FOV: 45 degrees.
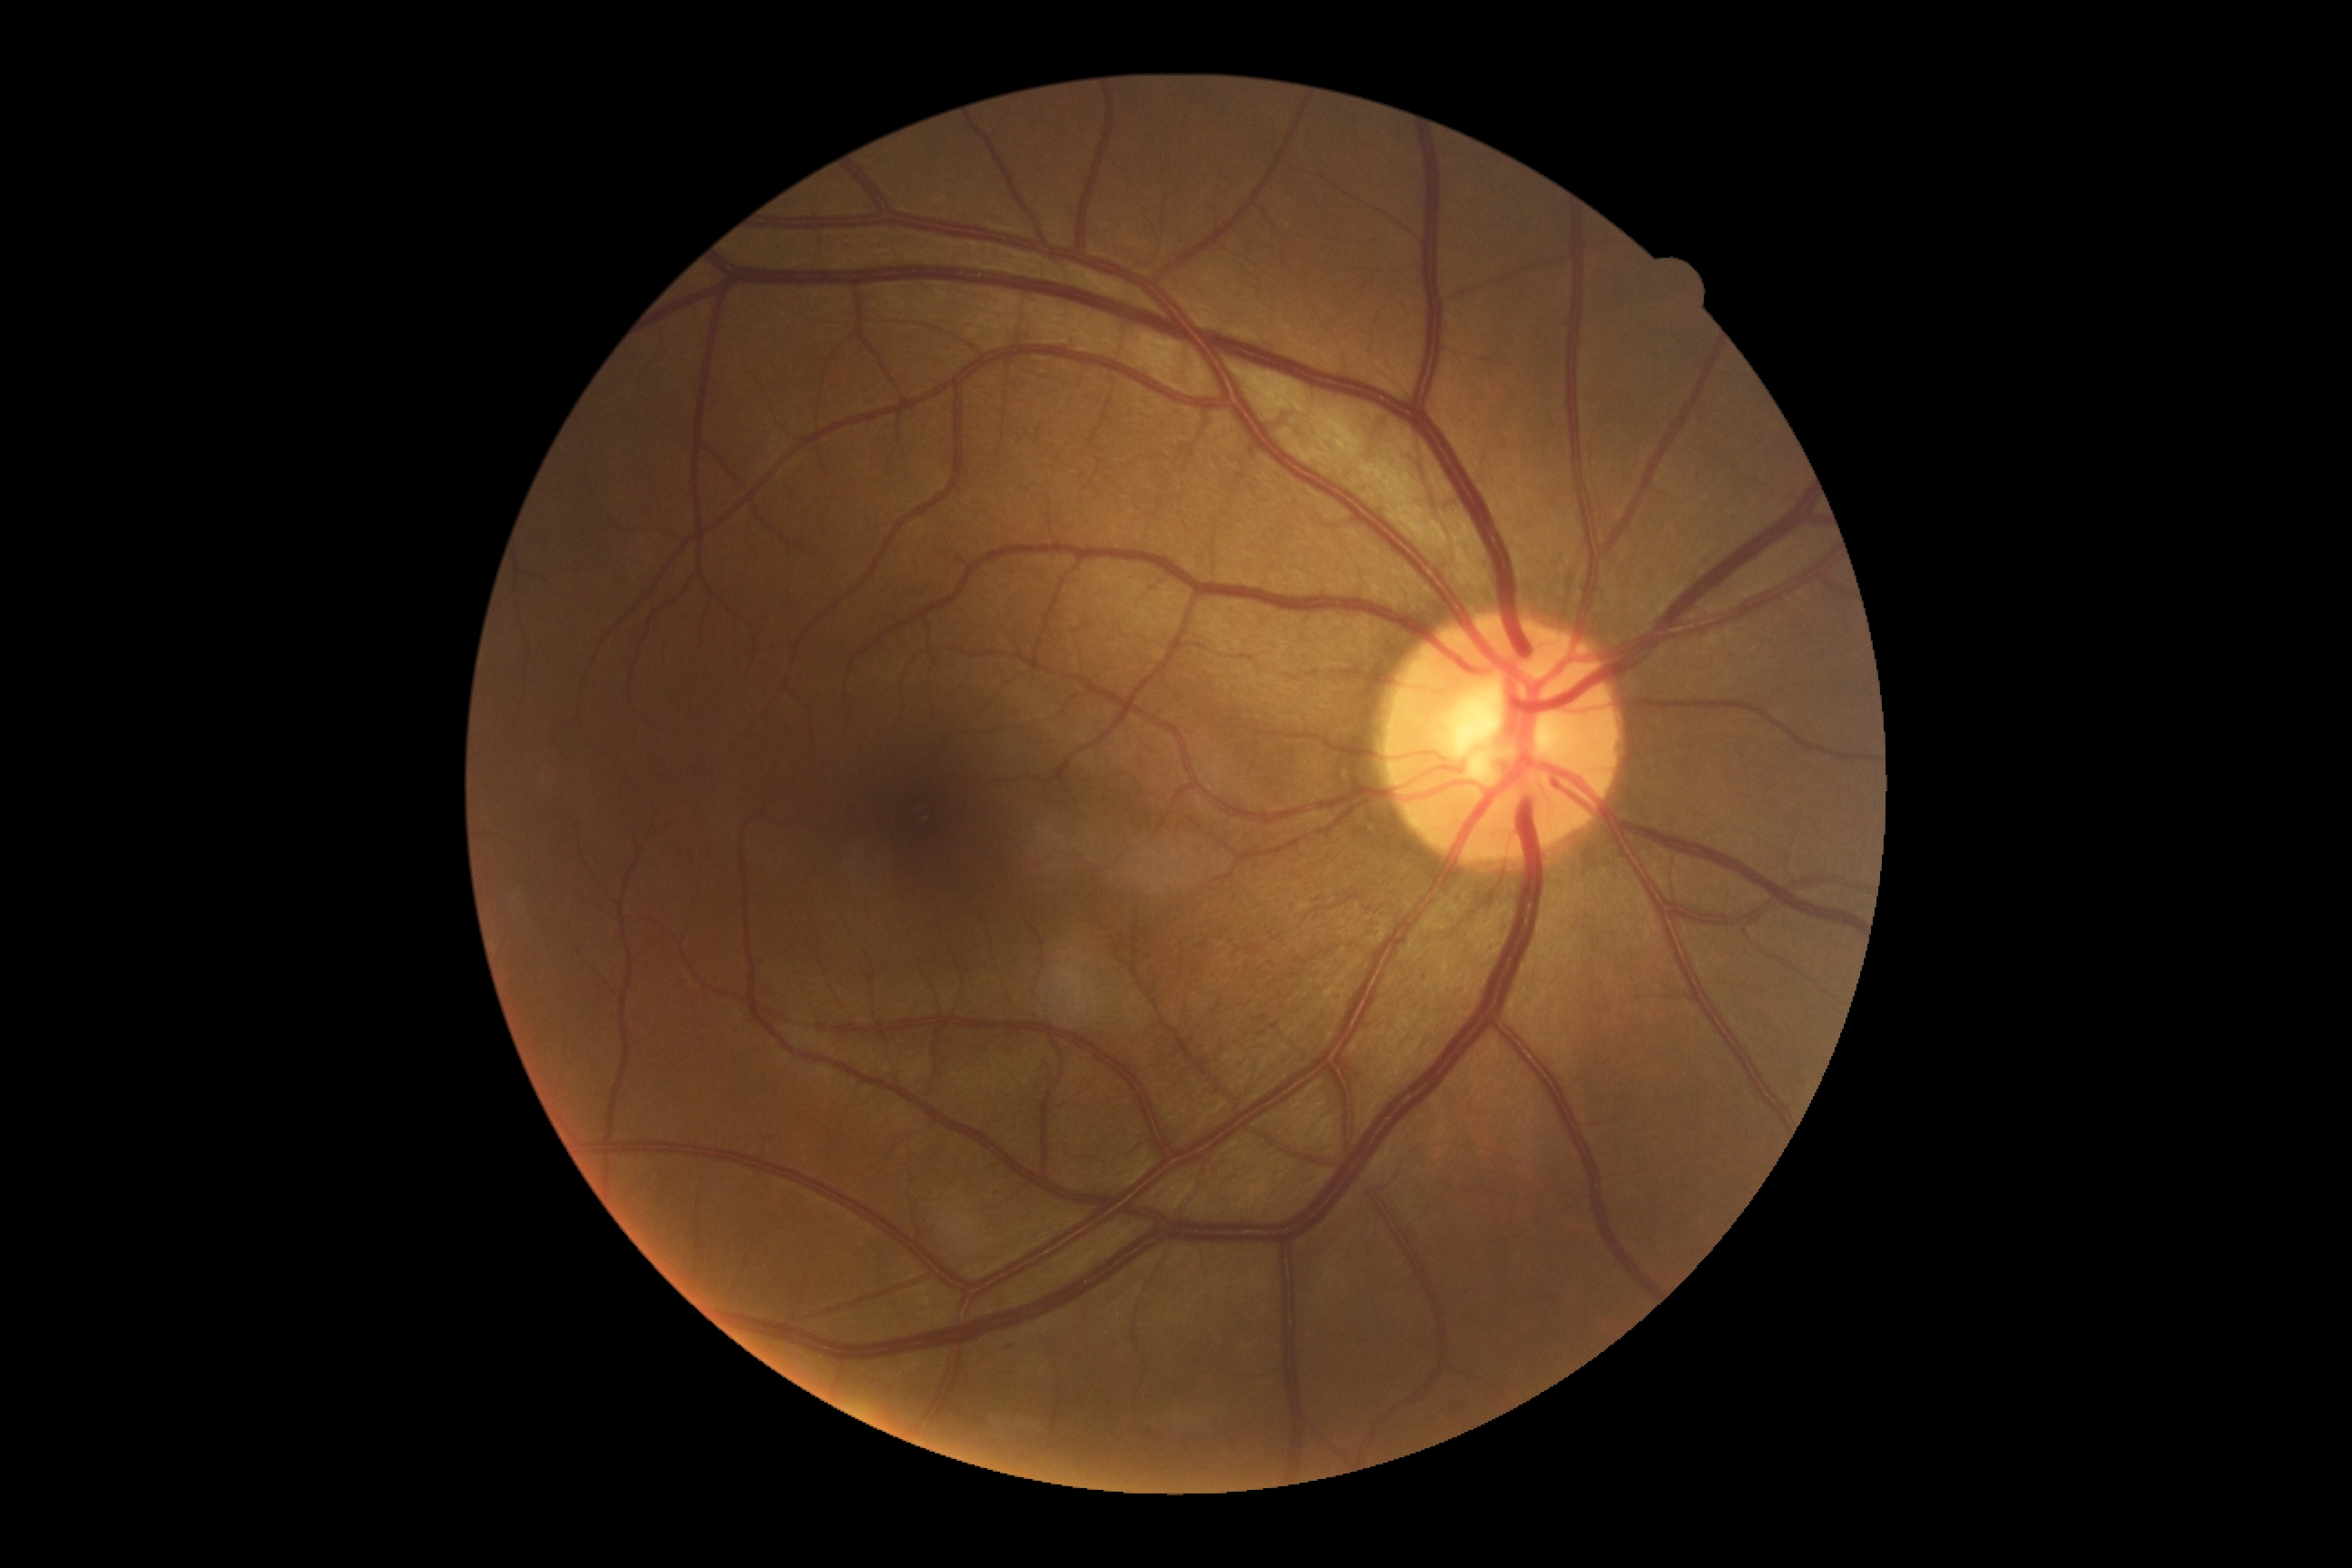
DR grade: mild non-proliferative diabetic retinopathy (1).